CFP — 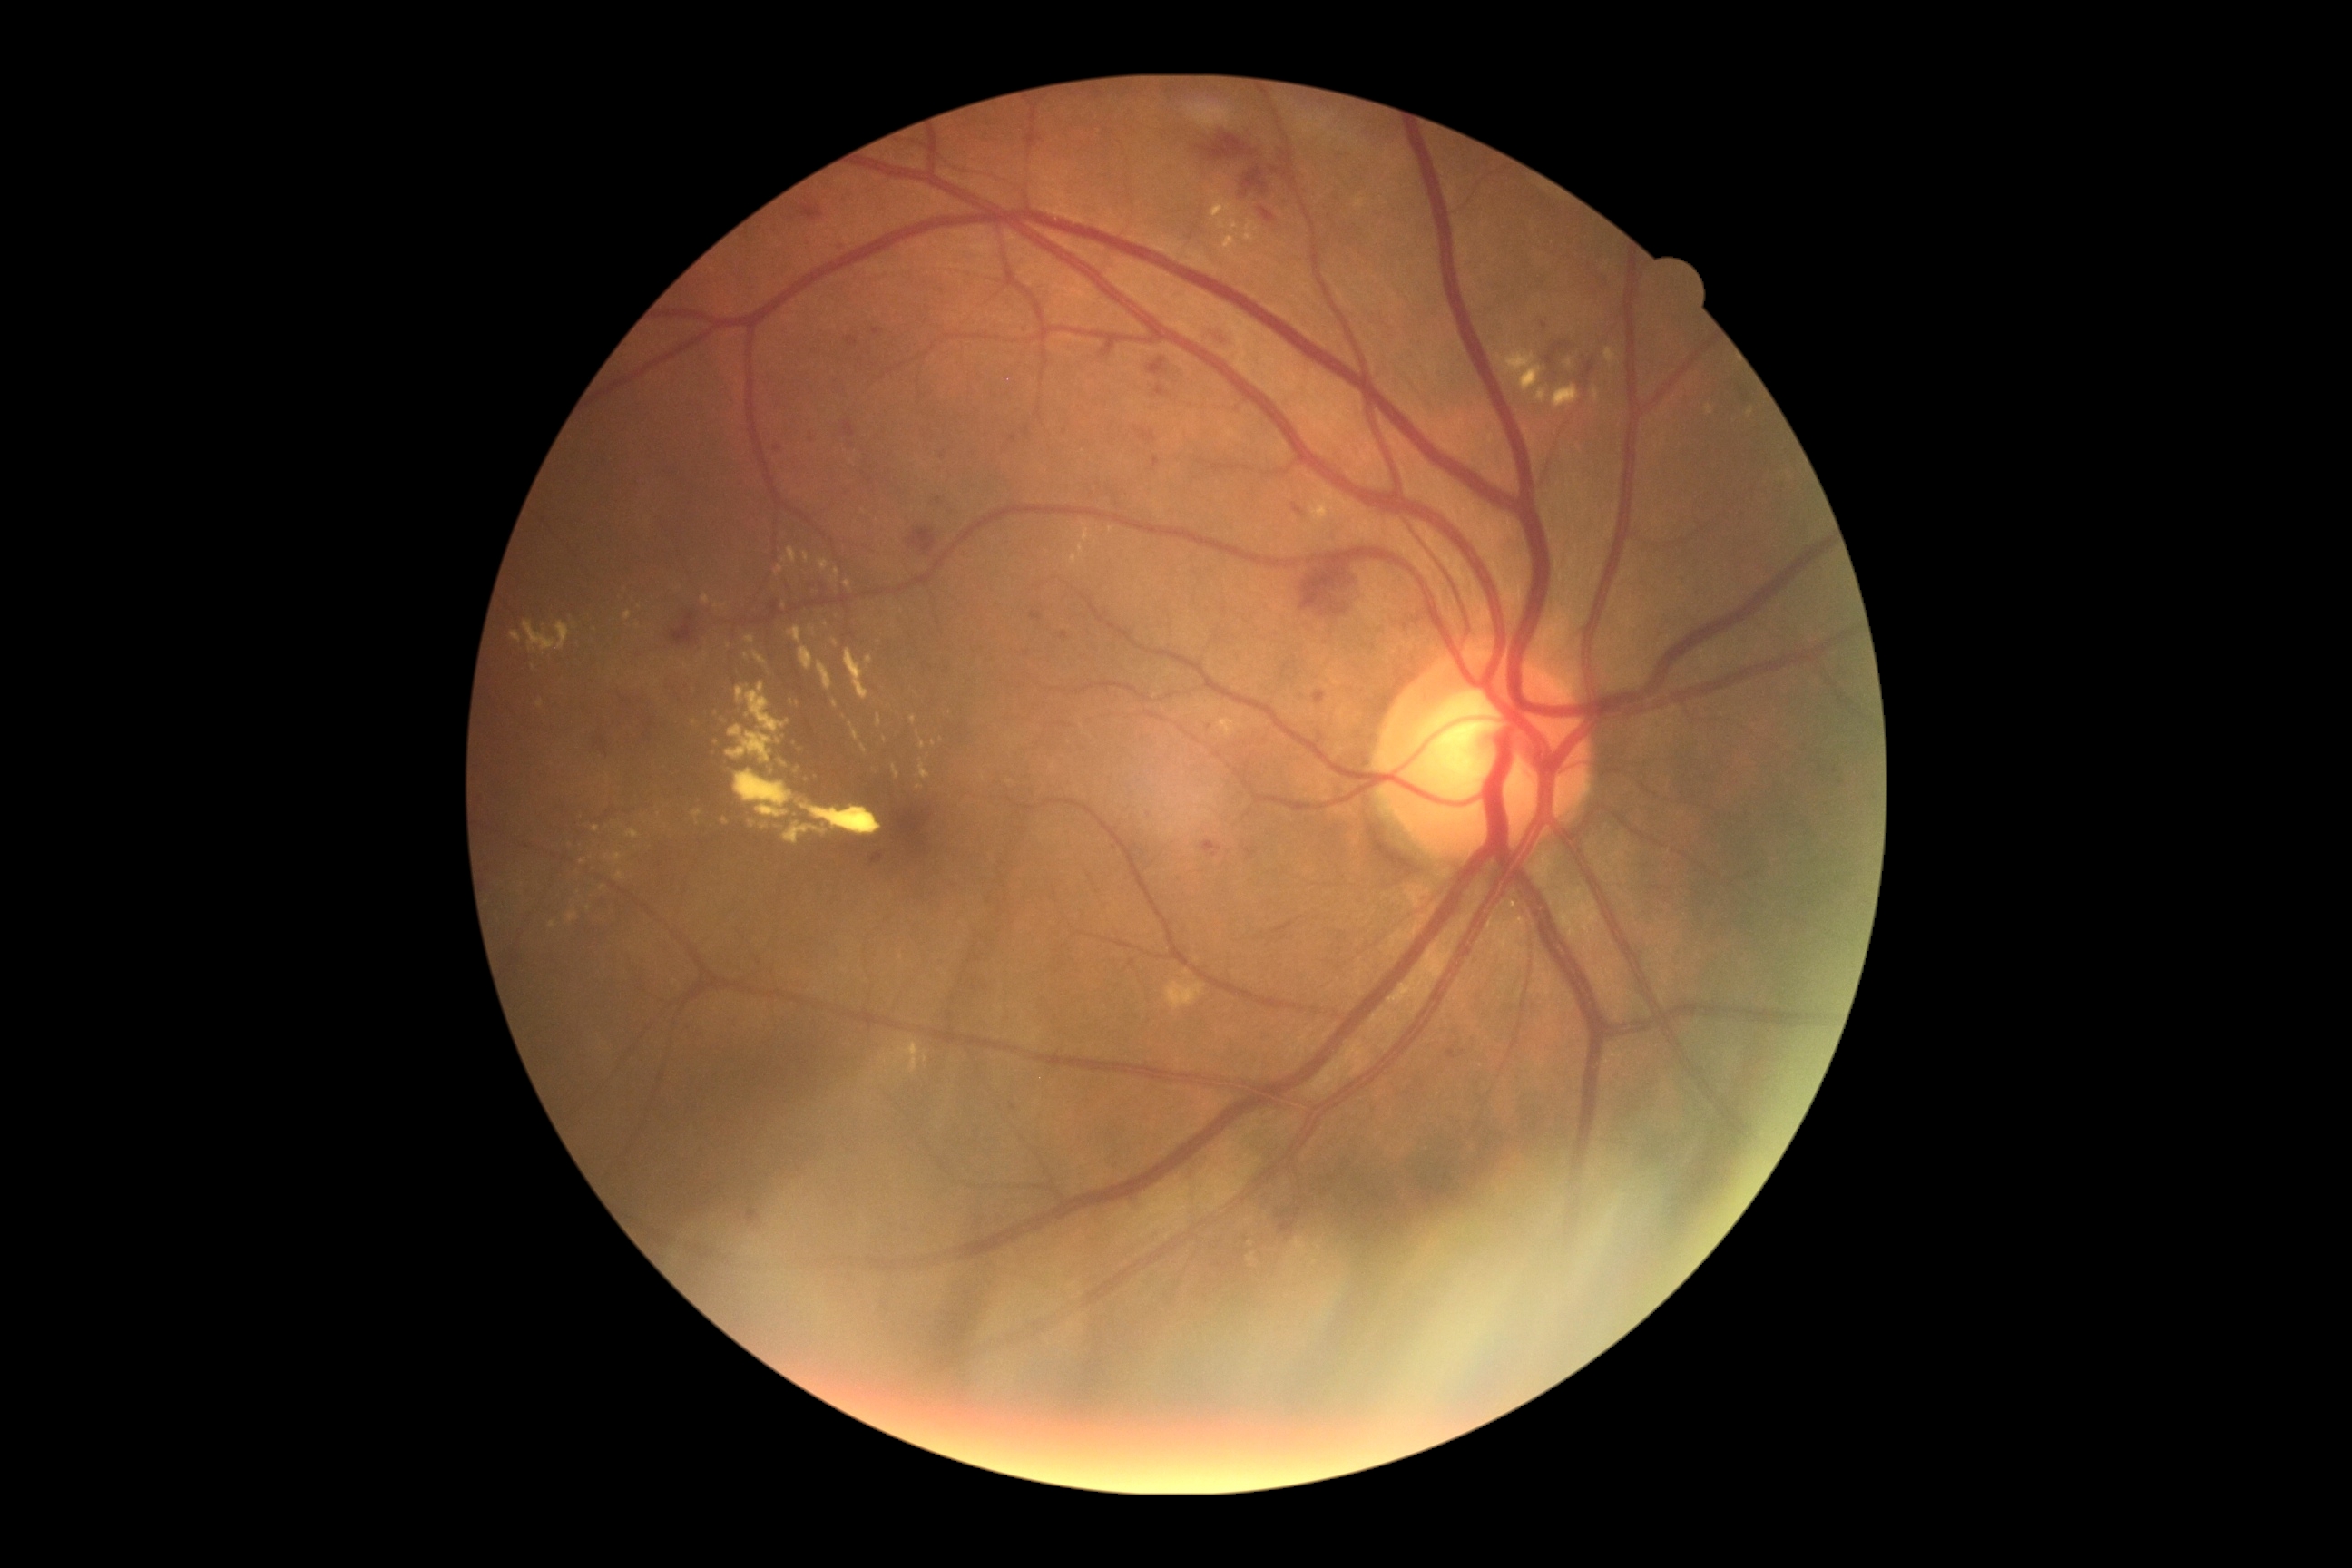
partial: true
dr_grade: 2
dr_grade_name: moderate NPDR
lesions:
  ex:
    - l=910, t=1059, r=919, b=1073
    - l=605, t=852, r=623, b=861
    - l=701, t=594, r=710, b=605
    - l=1215, t=197, r=1231, b=215
    - l=1083, t=529, r=1090, b=542
    - l=752, t=651, r=767, b=665
    - l=832, t=638, r=839, b=647
    - l=785, t=823, r=827, b=845
    - l=536, t=701, r=544, b=709
    - l=736, t=681, r=790, b=734
    - l=721, t=718, r=729, b=723
    - l=861, t=745, r=868, b=756
    - l=832, t=700, r=838, b=709
  ex_small:
    - 728:647
    - 1251:1243
    - 885:740
    - 901:957
    - 746:657
  he:
    - l=1547, t=342, r=1569, b=364
    - l=598, t=734, r=605, b=750
    - l=1315, t=691, r=1326, b=709
    - l=870, t=852, r=885, b=865
    - l=847, t=337, r=859, b=346
    - l=1148, t=358, r=1166, b=377
    - l=845, t=422, r=856, b=436
    - l=1271, t=168, r=1280, b=173
    - l=1259, t=208, r=1277, b=224
    - l=1295, t=1208, r=1302, b=1219
    - l=801, t=204, r=825, b=220
    - l=1197, t=135, r=1257, b=161
    - l=1242, t=168, r=1269, b=197